FOV: 45 degrees; color fundus photograph.
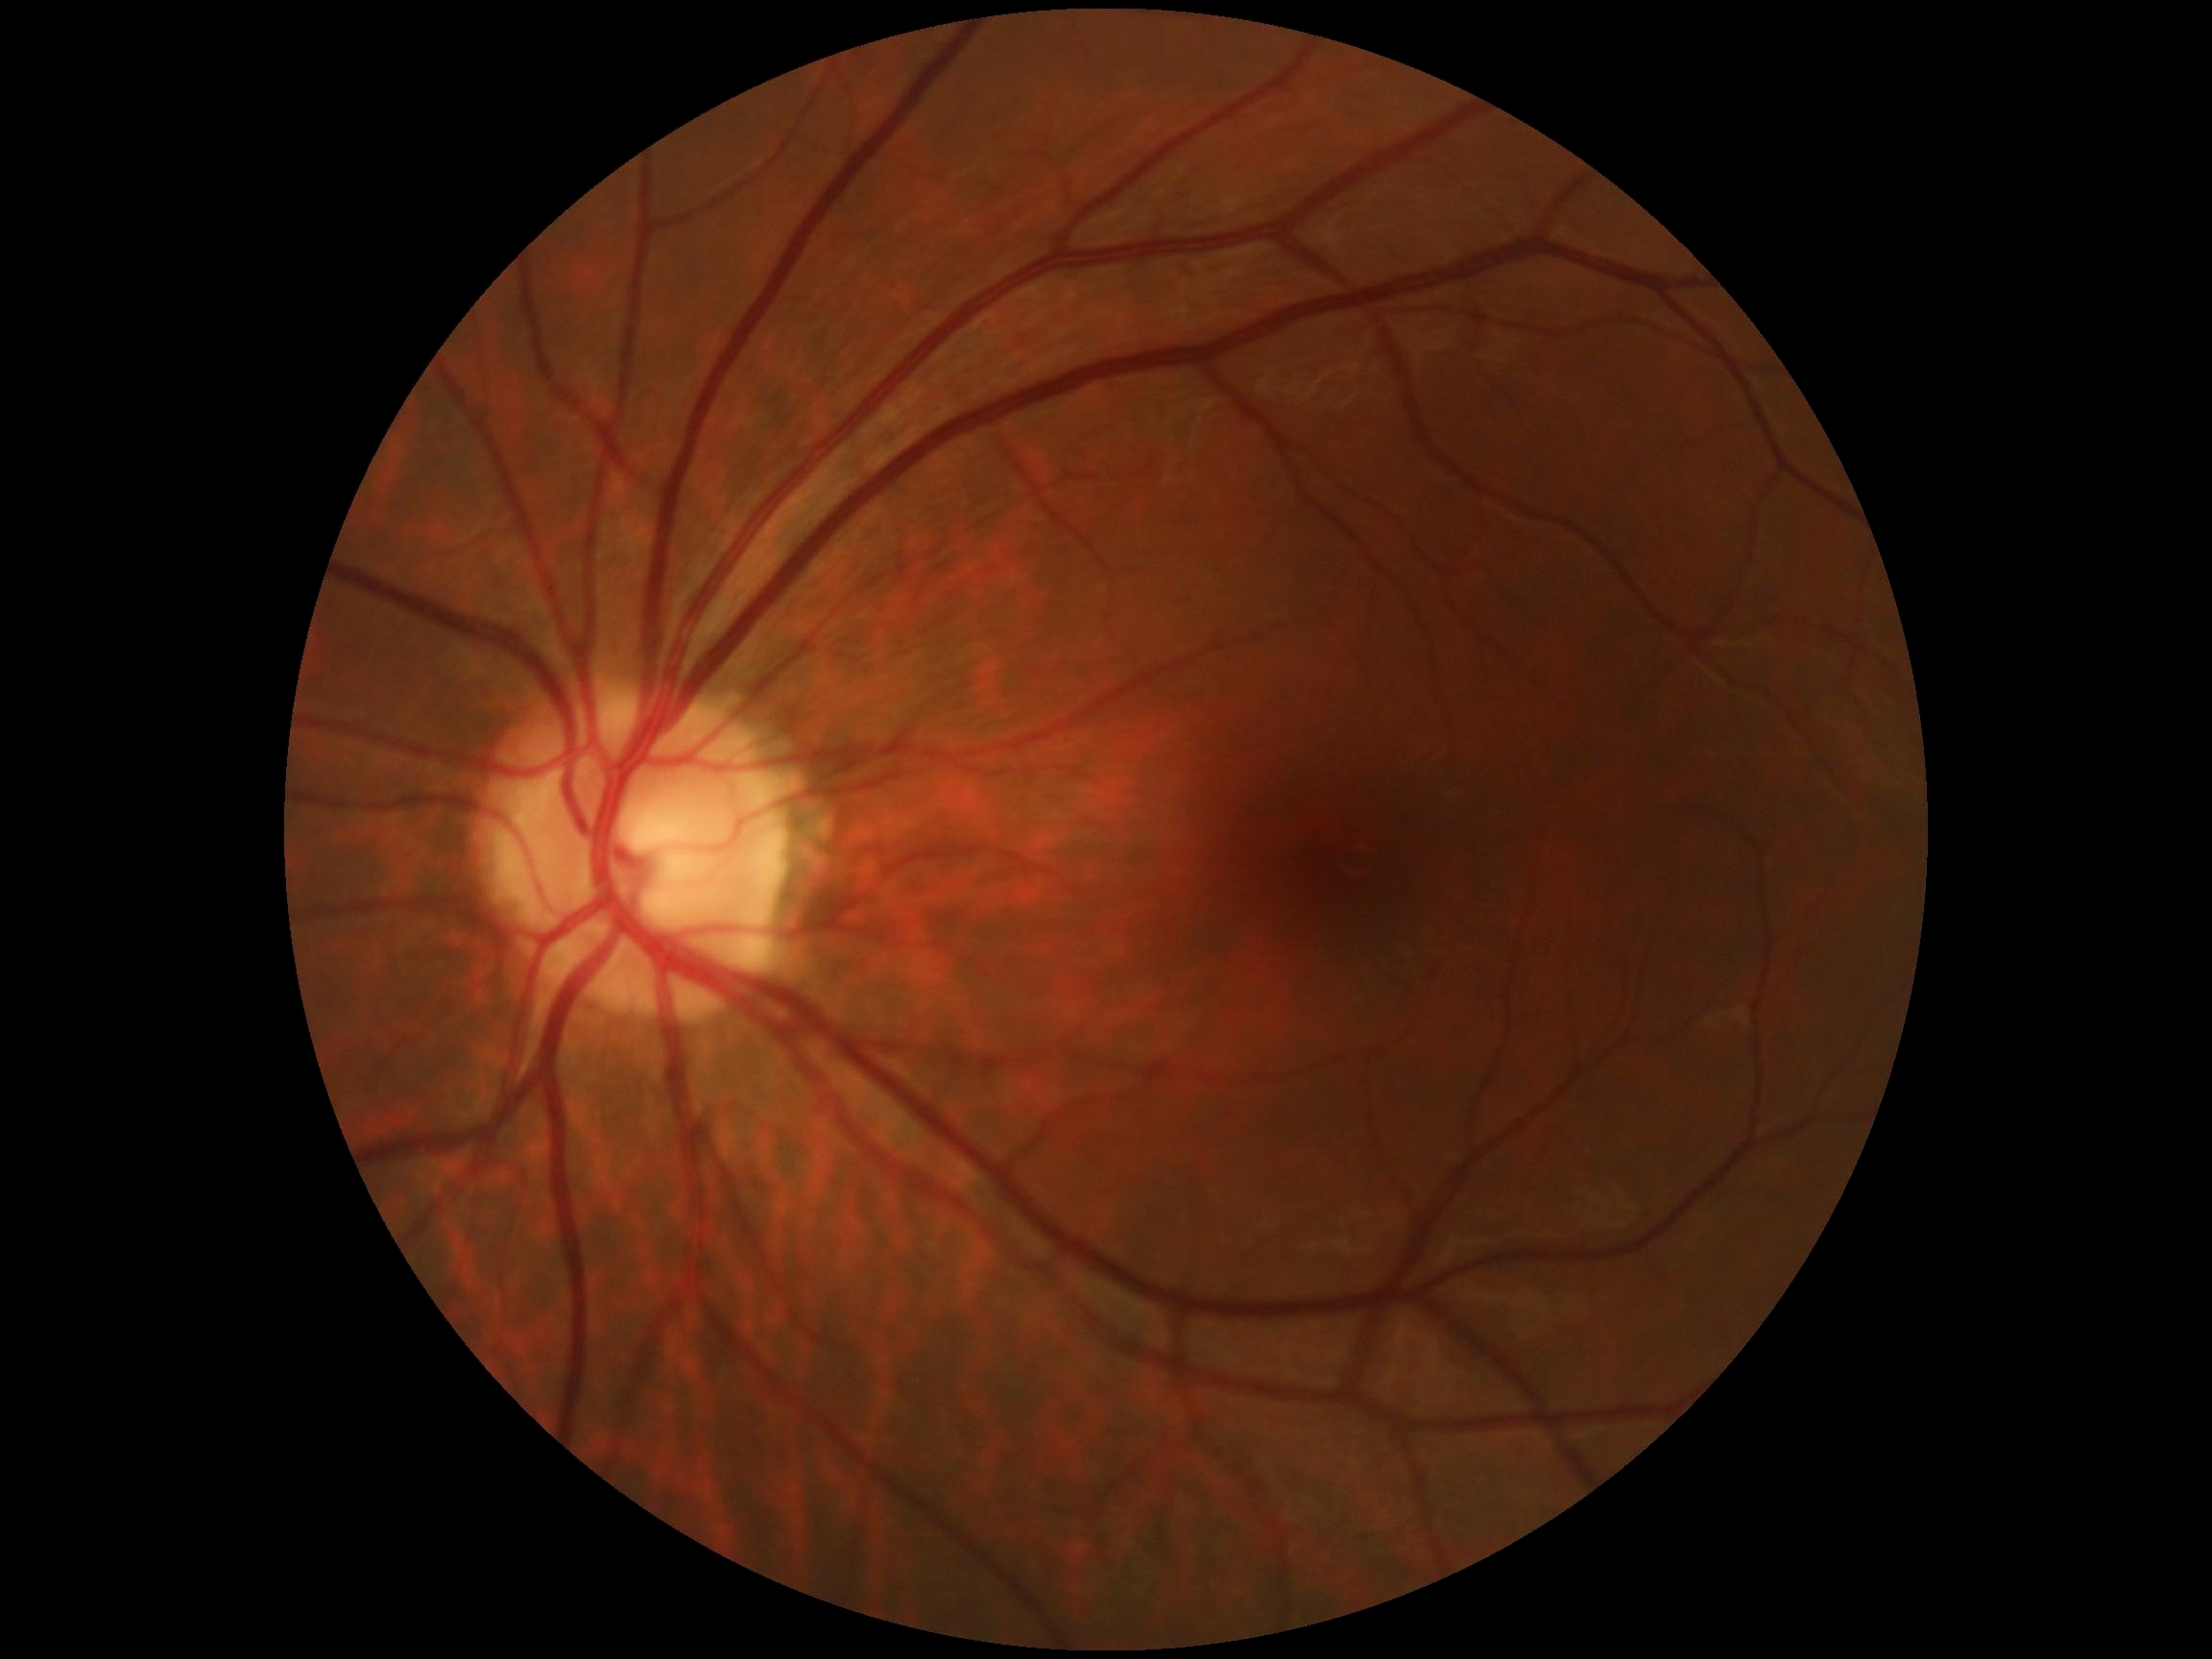
Diabetic retinopathy (DR): 0/4.